CFP. 45° field of view:
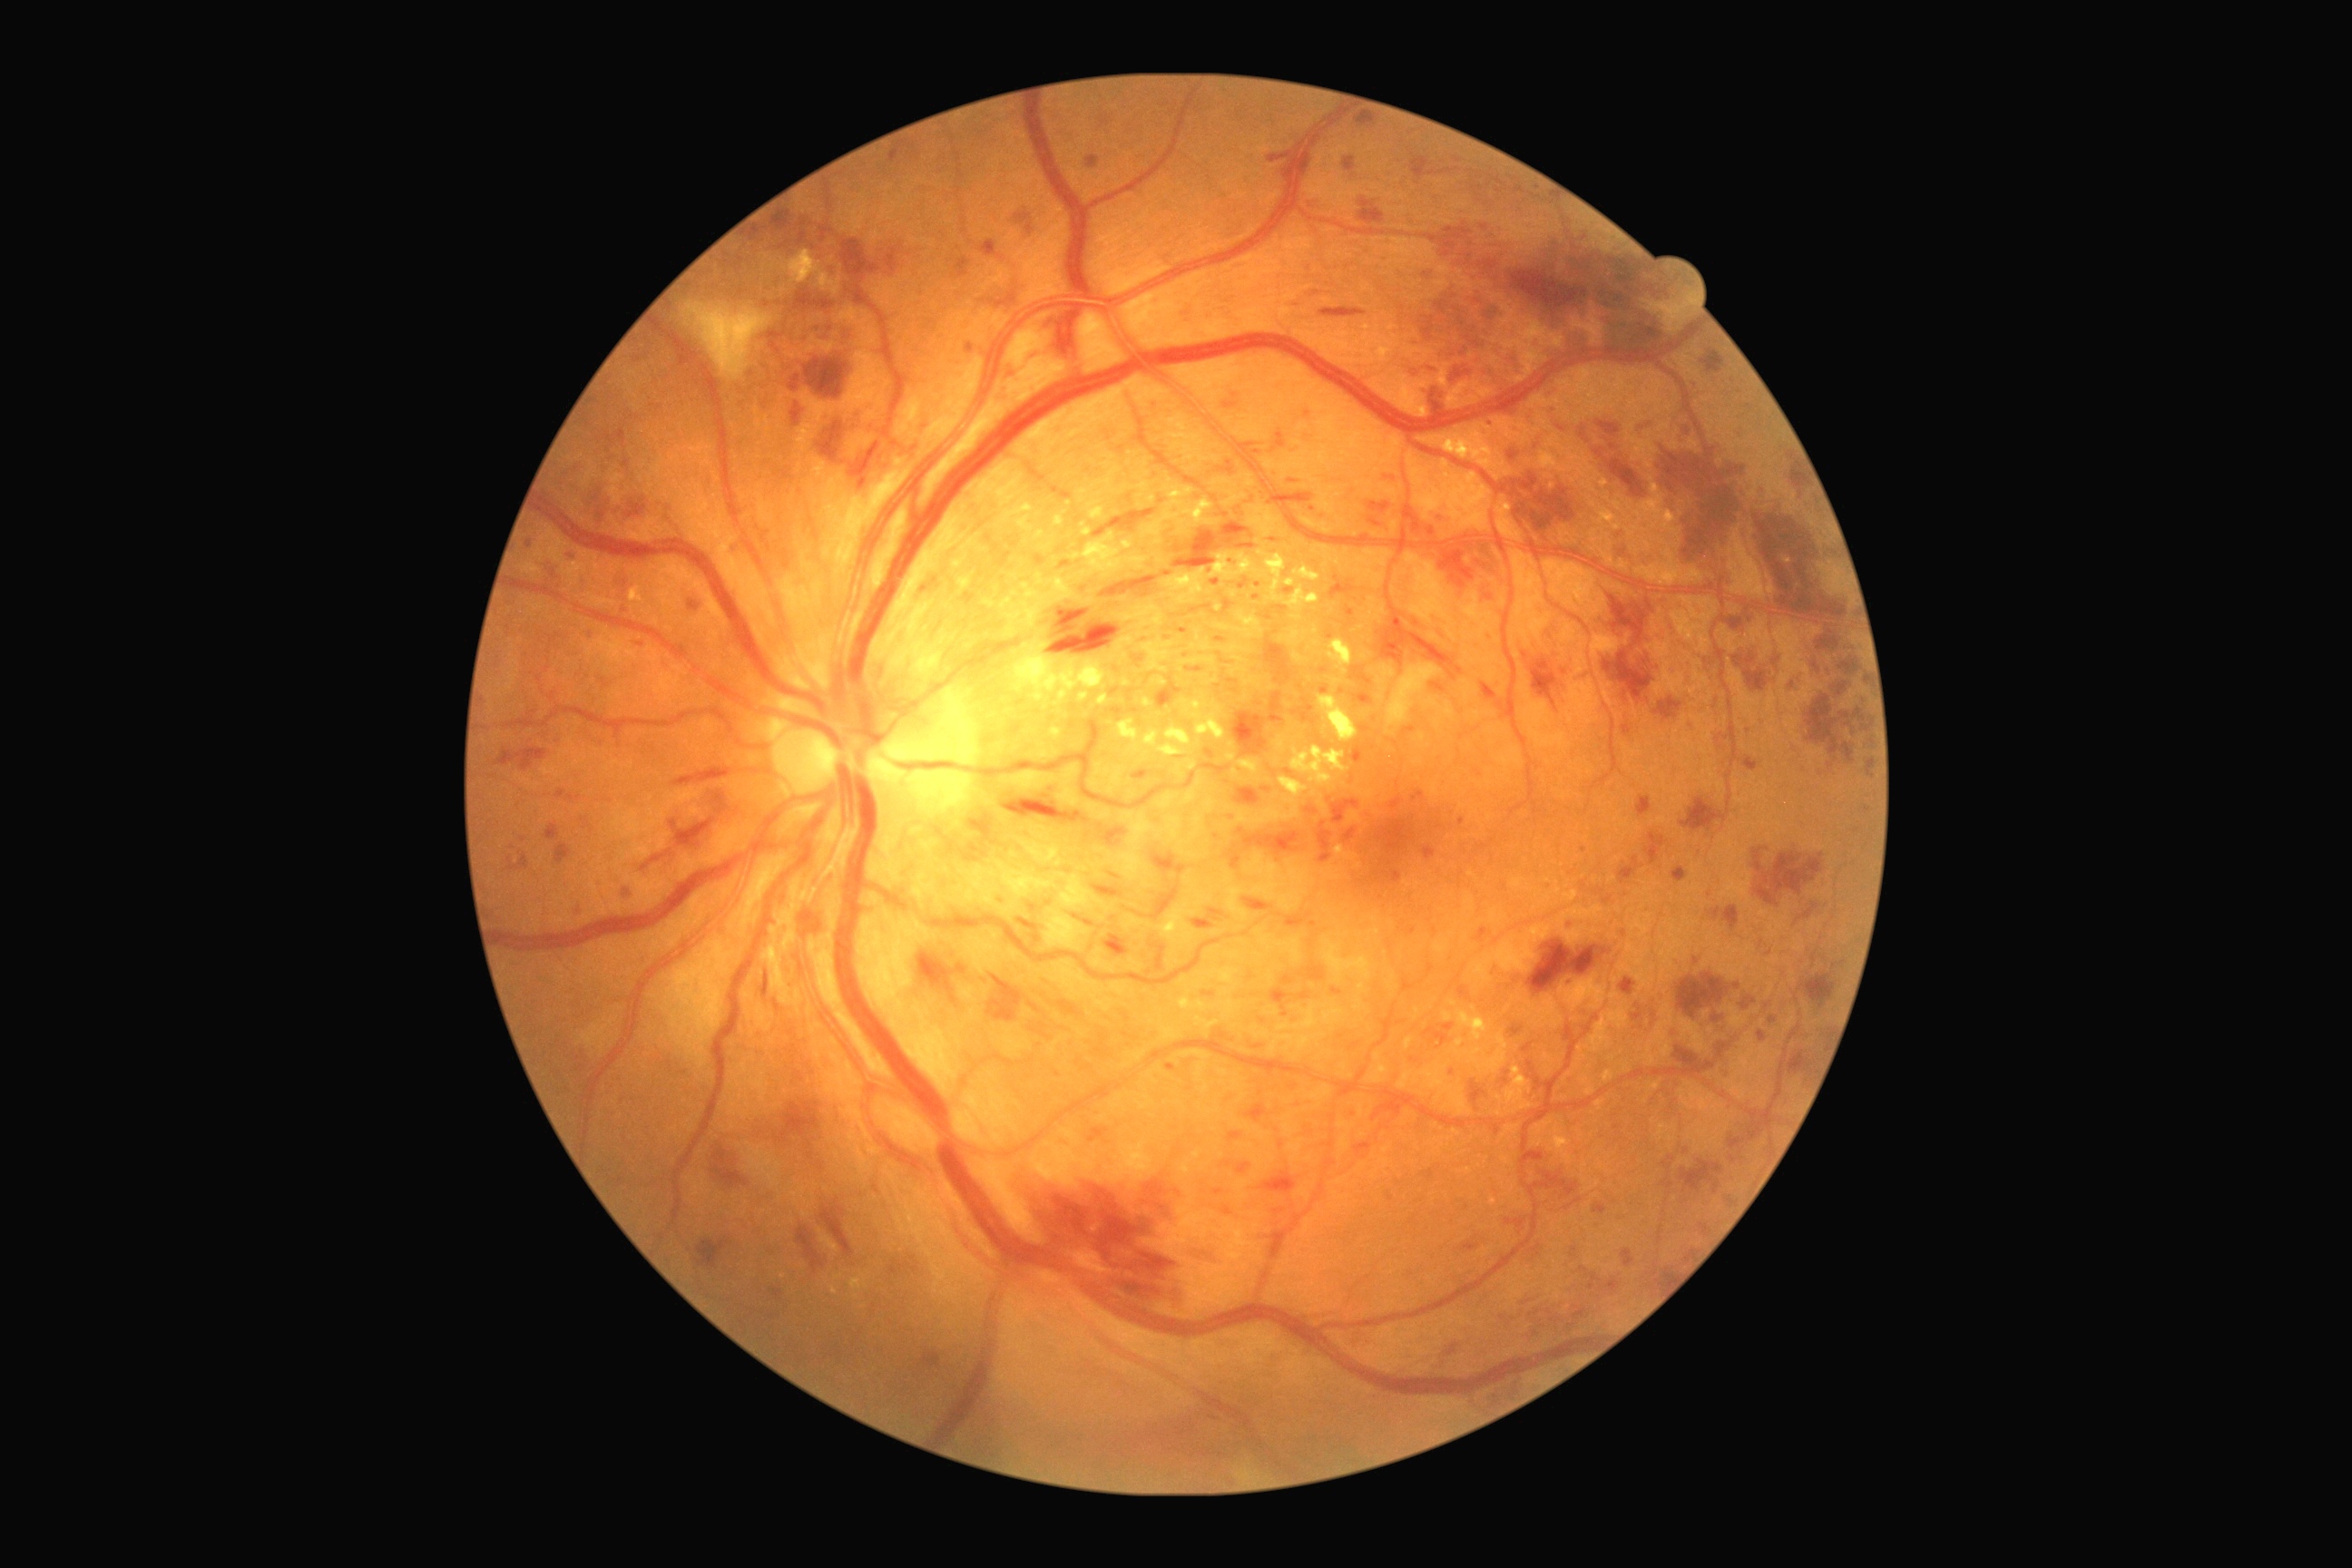 DR severity: 3
Selected lesions:
MAs (continued): bbox=[1387, 1193, 1395, 1202] | bbox=[1685, 1251, 1694, 1260] | bbox=[1224, 600, 1233, 614] | bbox=[618, 576, 625, 591] | bbox=[1545, 389, 1553, 400] | bbox=[1449, 1344, 1458, 1355] | bbox=[1505, 1219, 1527, 1231] | bbox=[1101, 115, 1112, 130] | bbox=[789, 375, 801, 393] | bbox=[761, 972, 769, 997] | bbox=[1275, 607, 1286, 611] | bbox=[1271, 988, 1289, 1010] | bbox=[1262, 789, 1271, 794]
Small MAs near [x=1748, y=732] | [x=1256, y=453] | [x=1867, y=810] | [x=1312, y=510] | [x=605, y=683] | [x=1453, y=1072]